Retinal fundus photograph
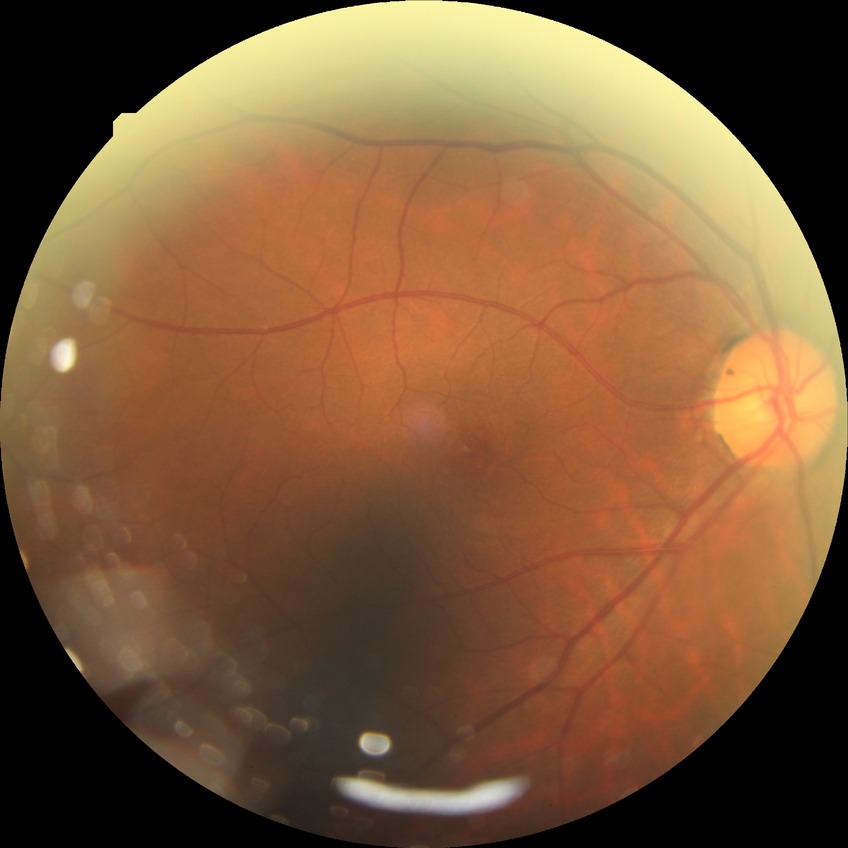

Diabetic retinopathy (DR): no diabetic retinopathy (NDR).